Color fundus photograph.
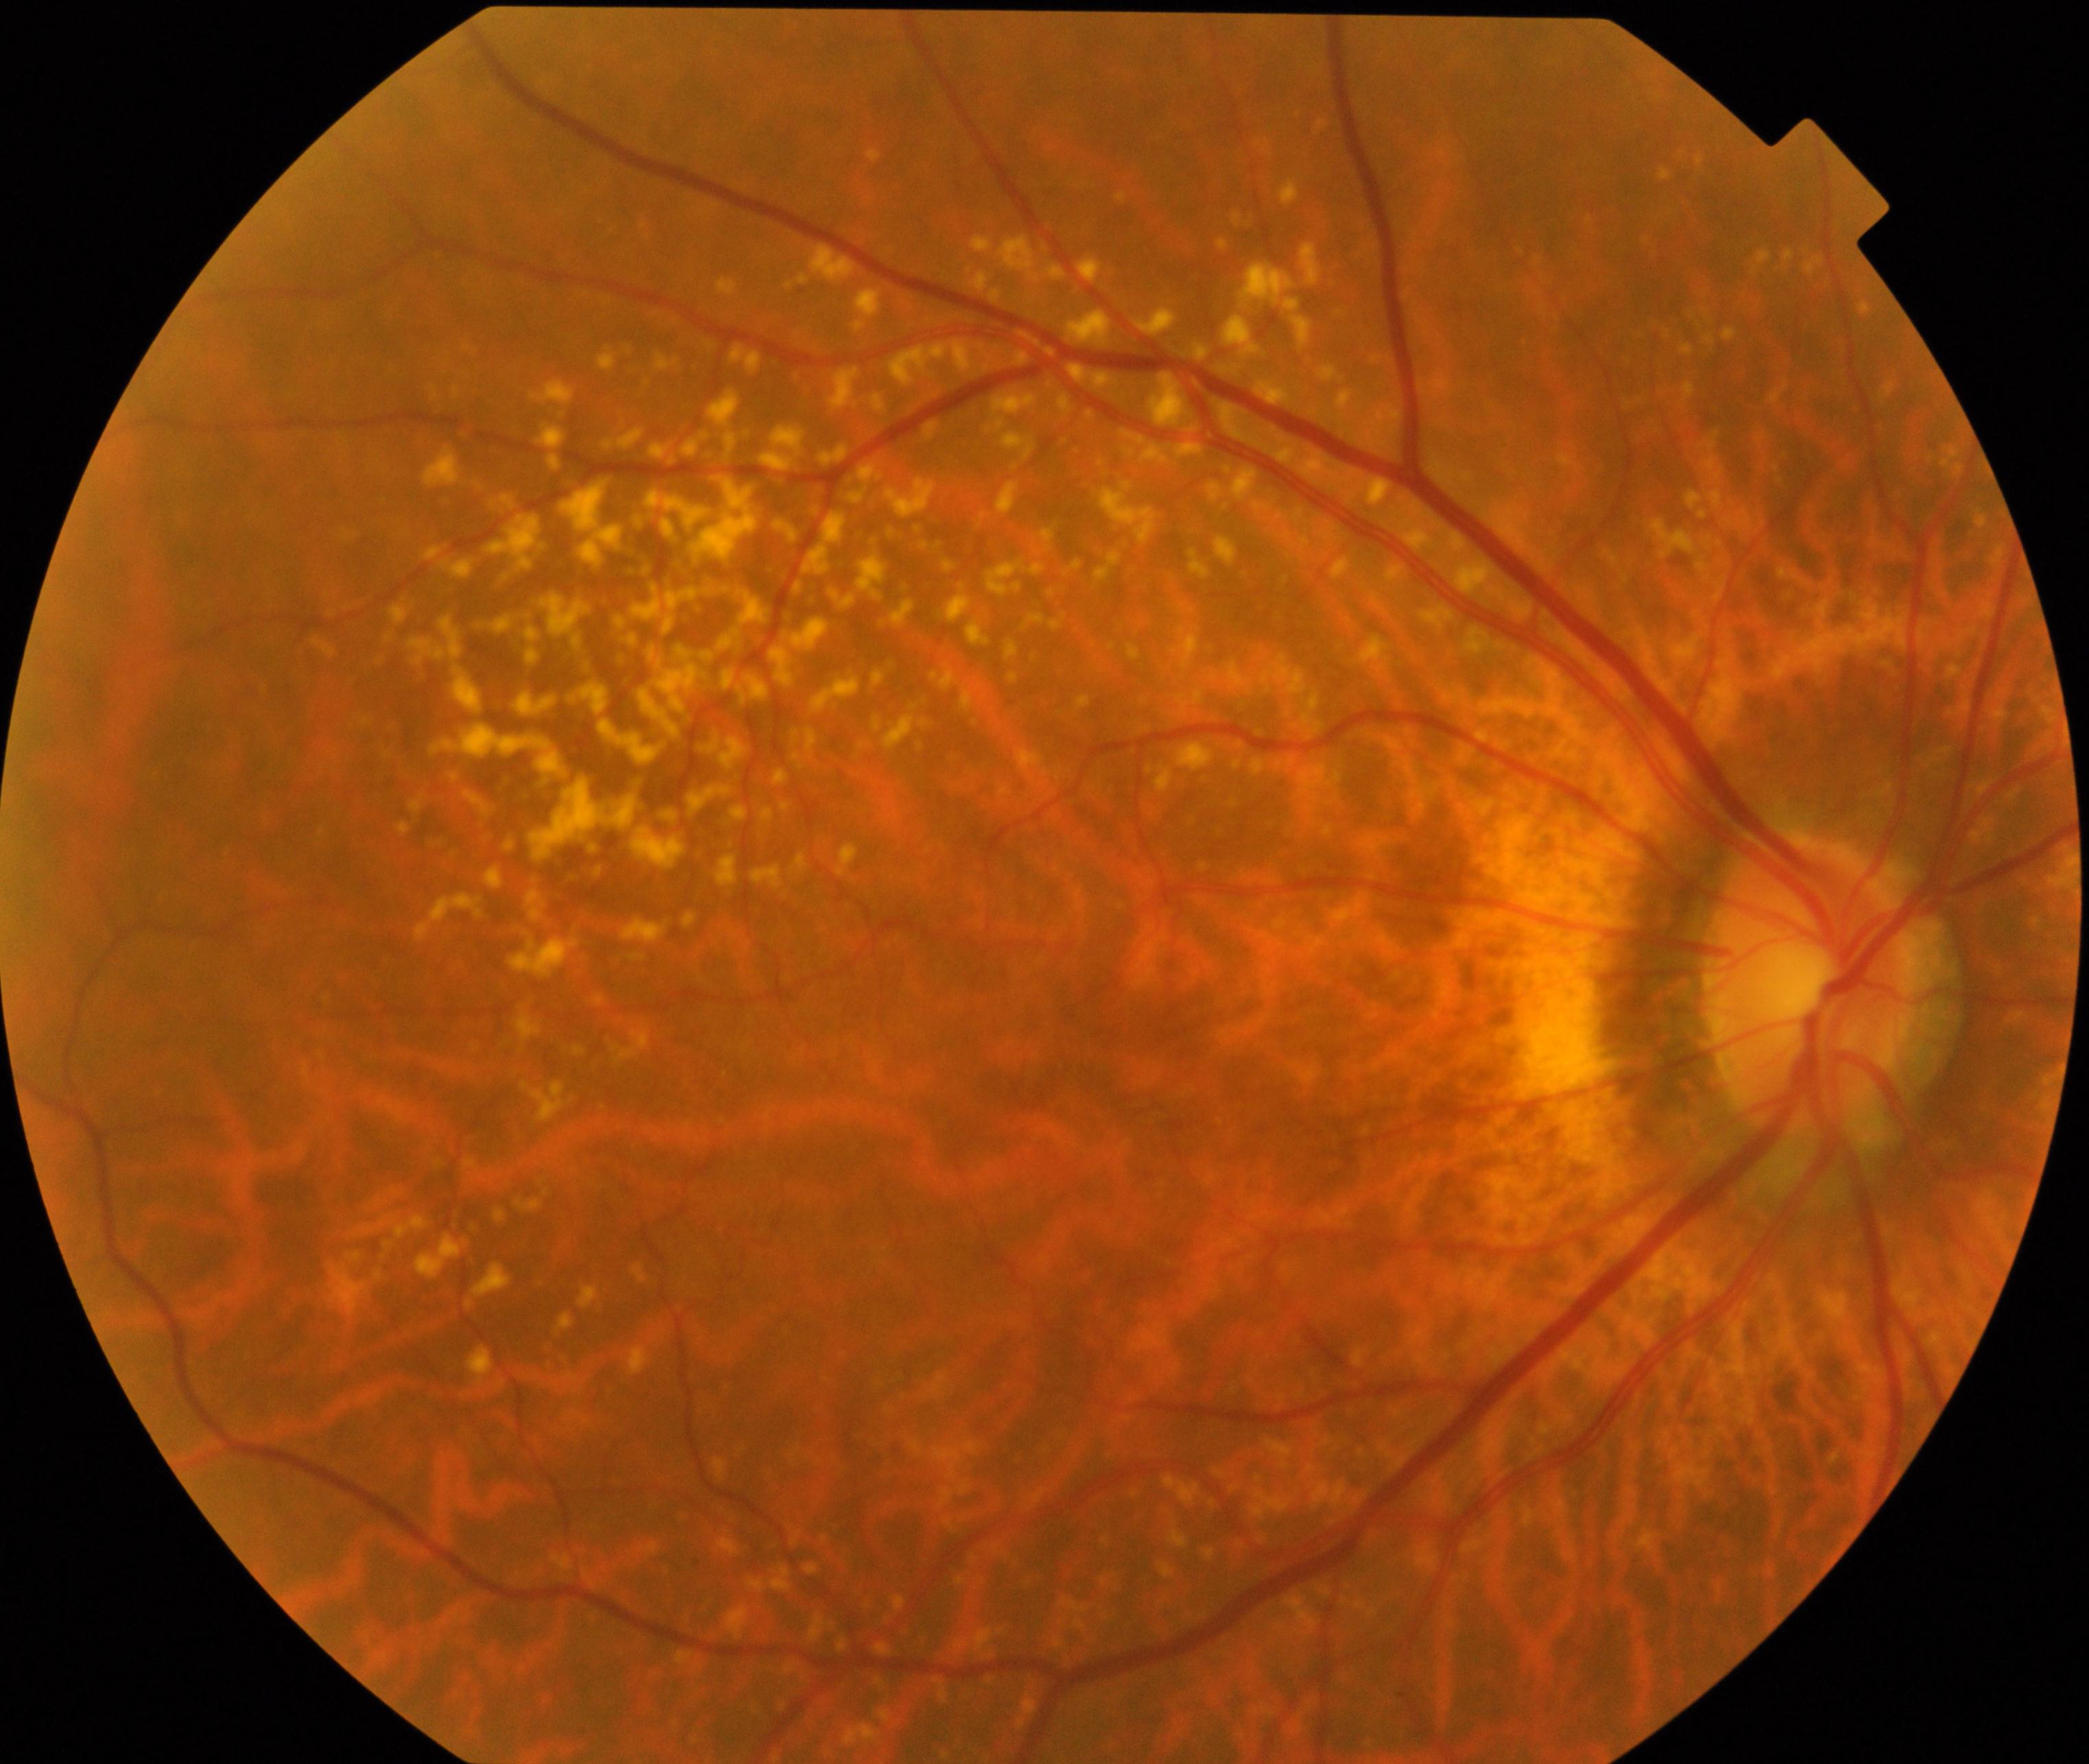

Findings: yellow-white spots or flecks.